848 by 848 pixels, camera: NIDEK AFC-230, graded on the modified Davis scale:
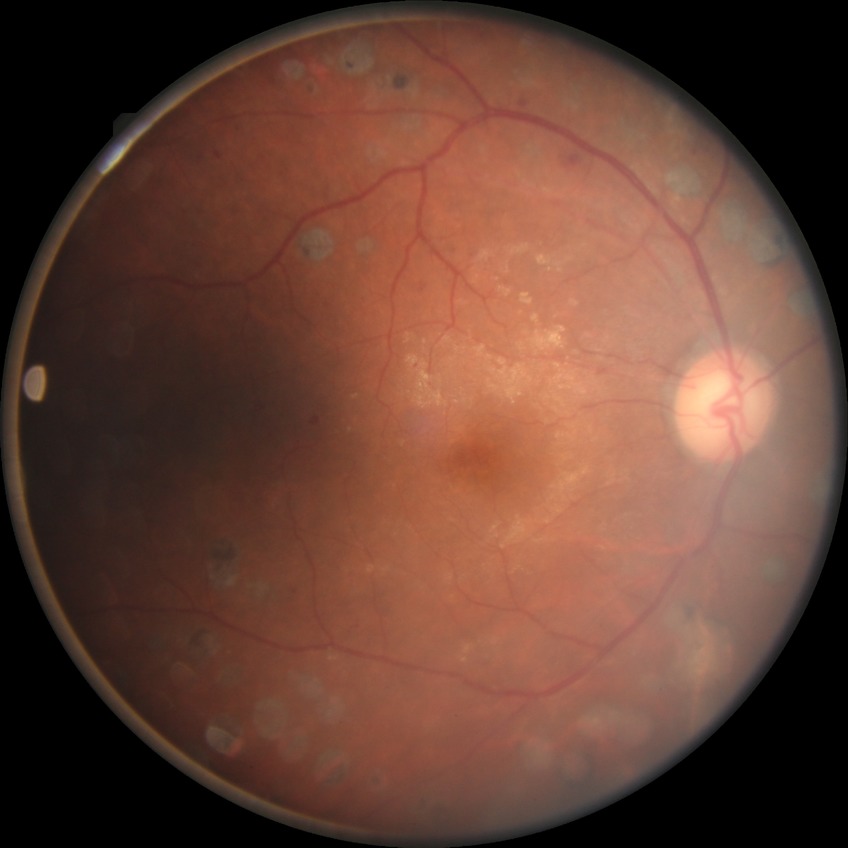
Diabetic retinopathy stage is proliferative diabetic retinopathy.